45° FOV:
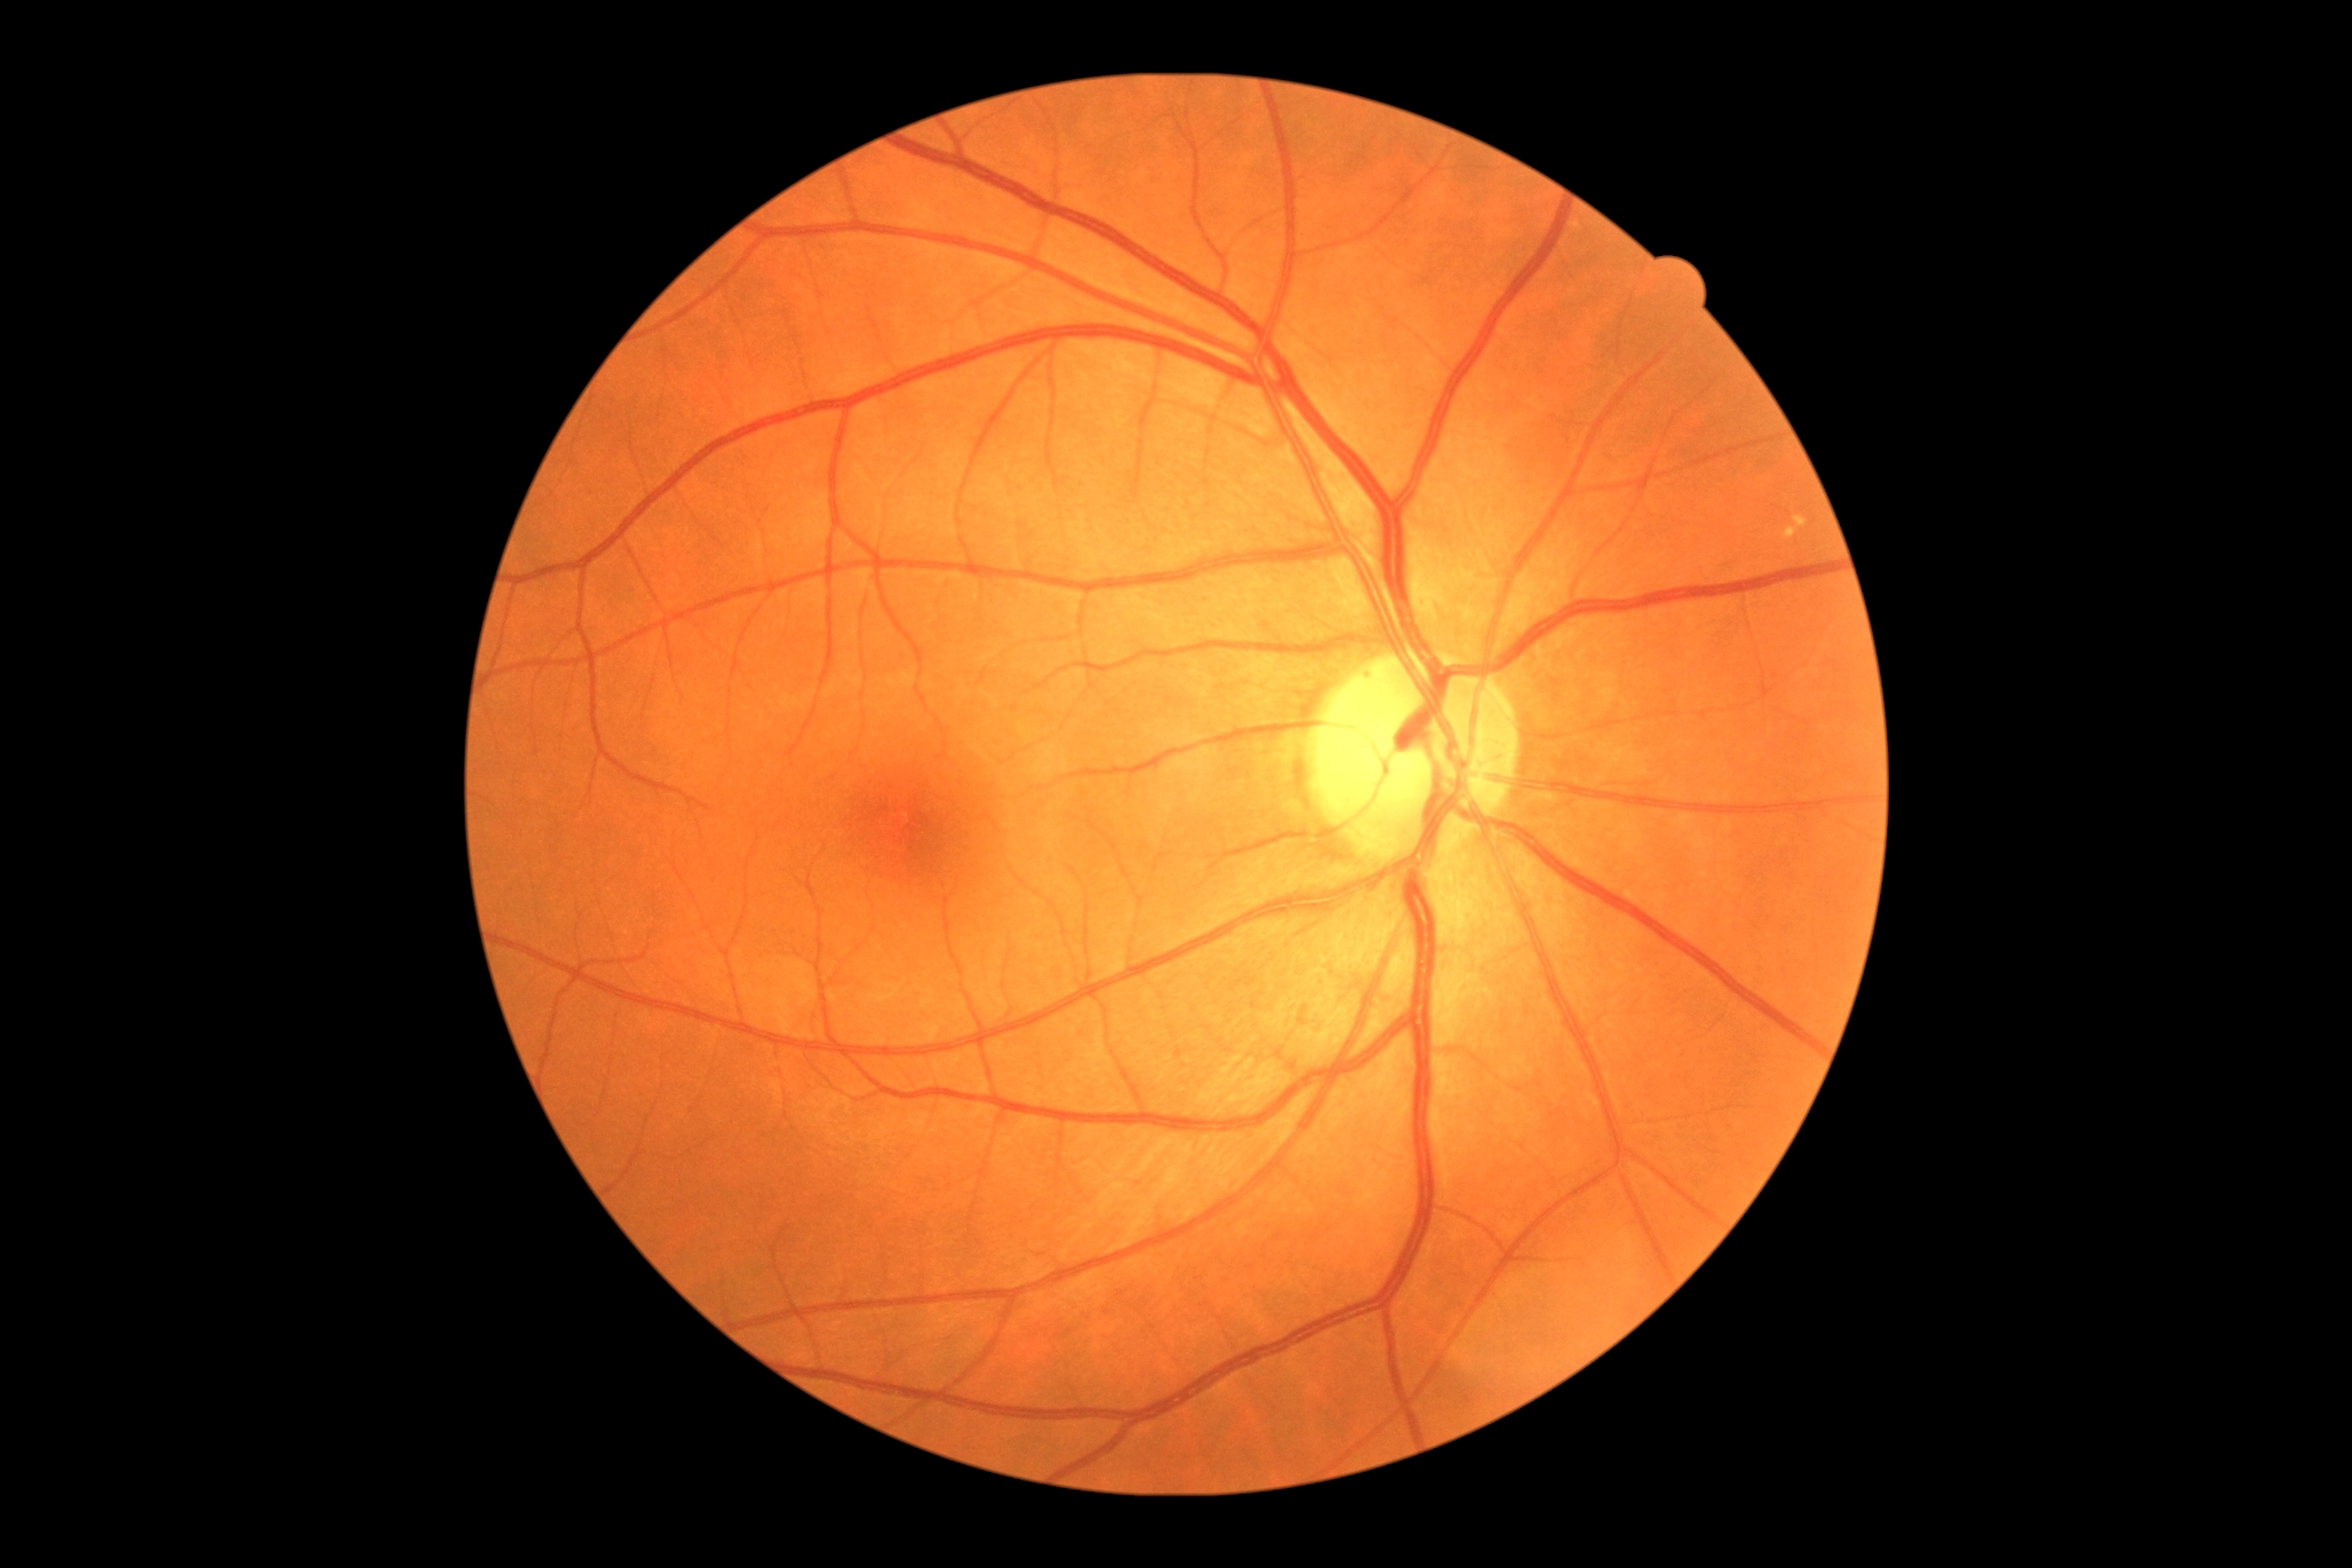

diabetic retinopathy (DR): grade 2 (moderate NPDR).